Infant wide-field fundus photograph — 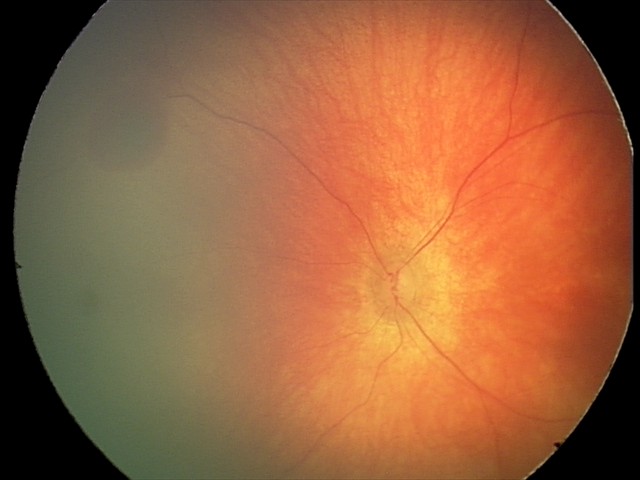
Examination diagnosed as retinal hemorrhages.